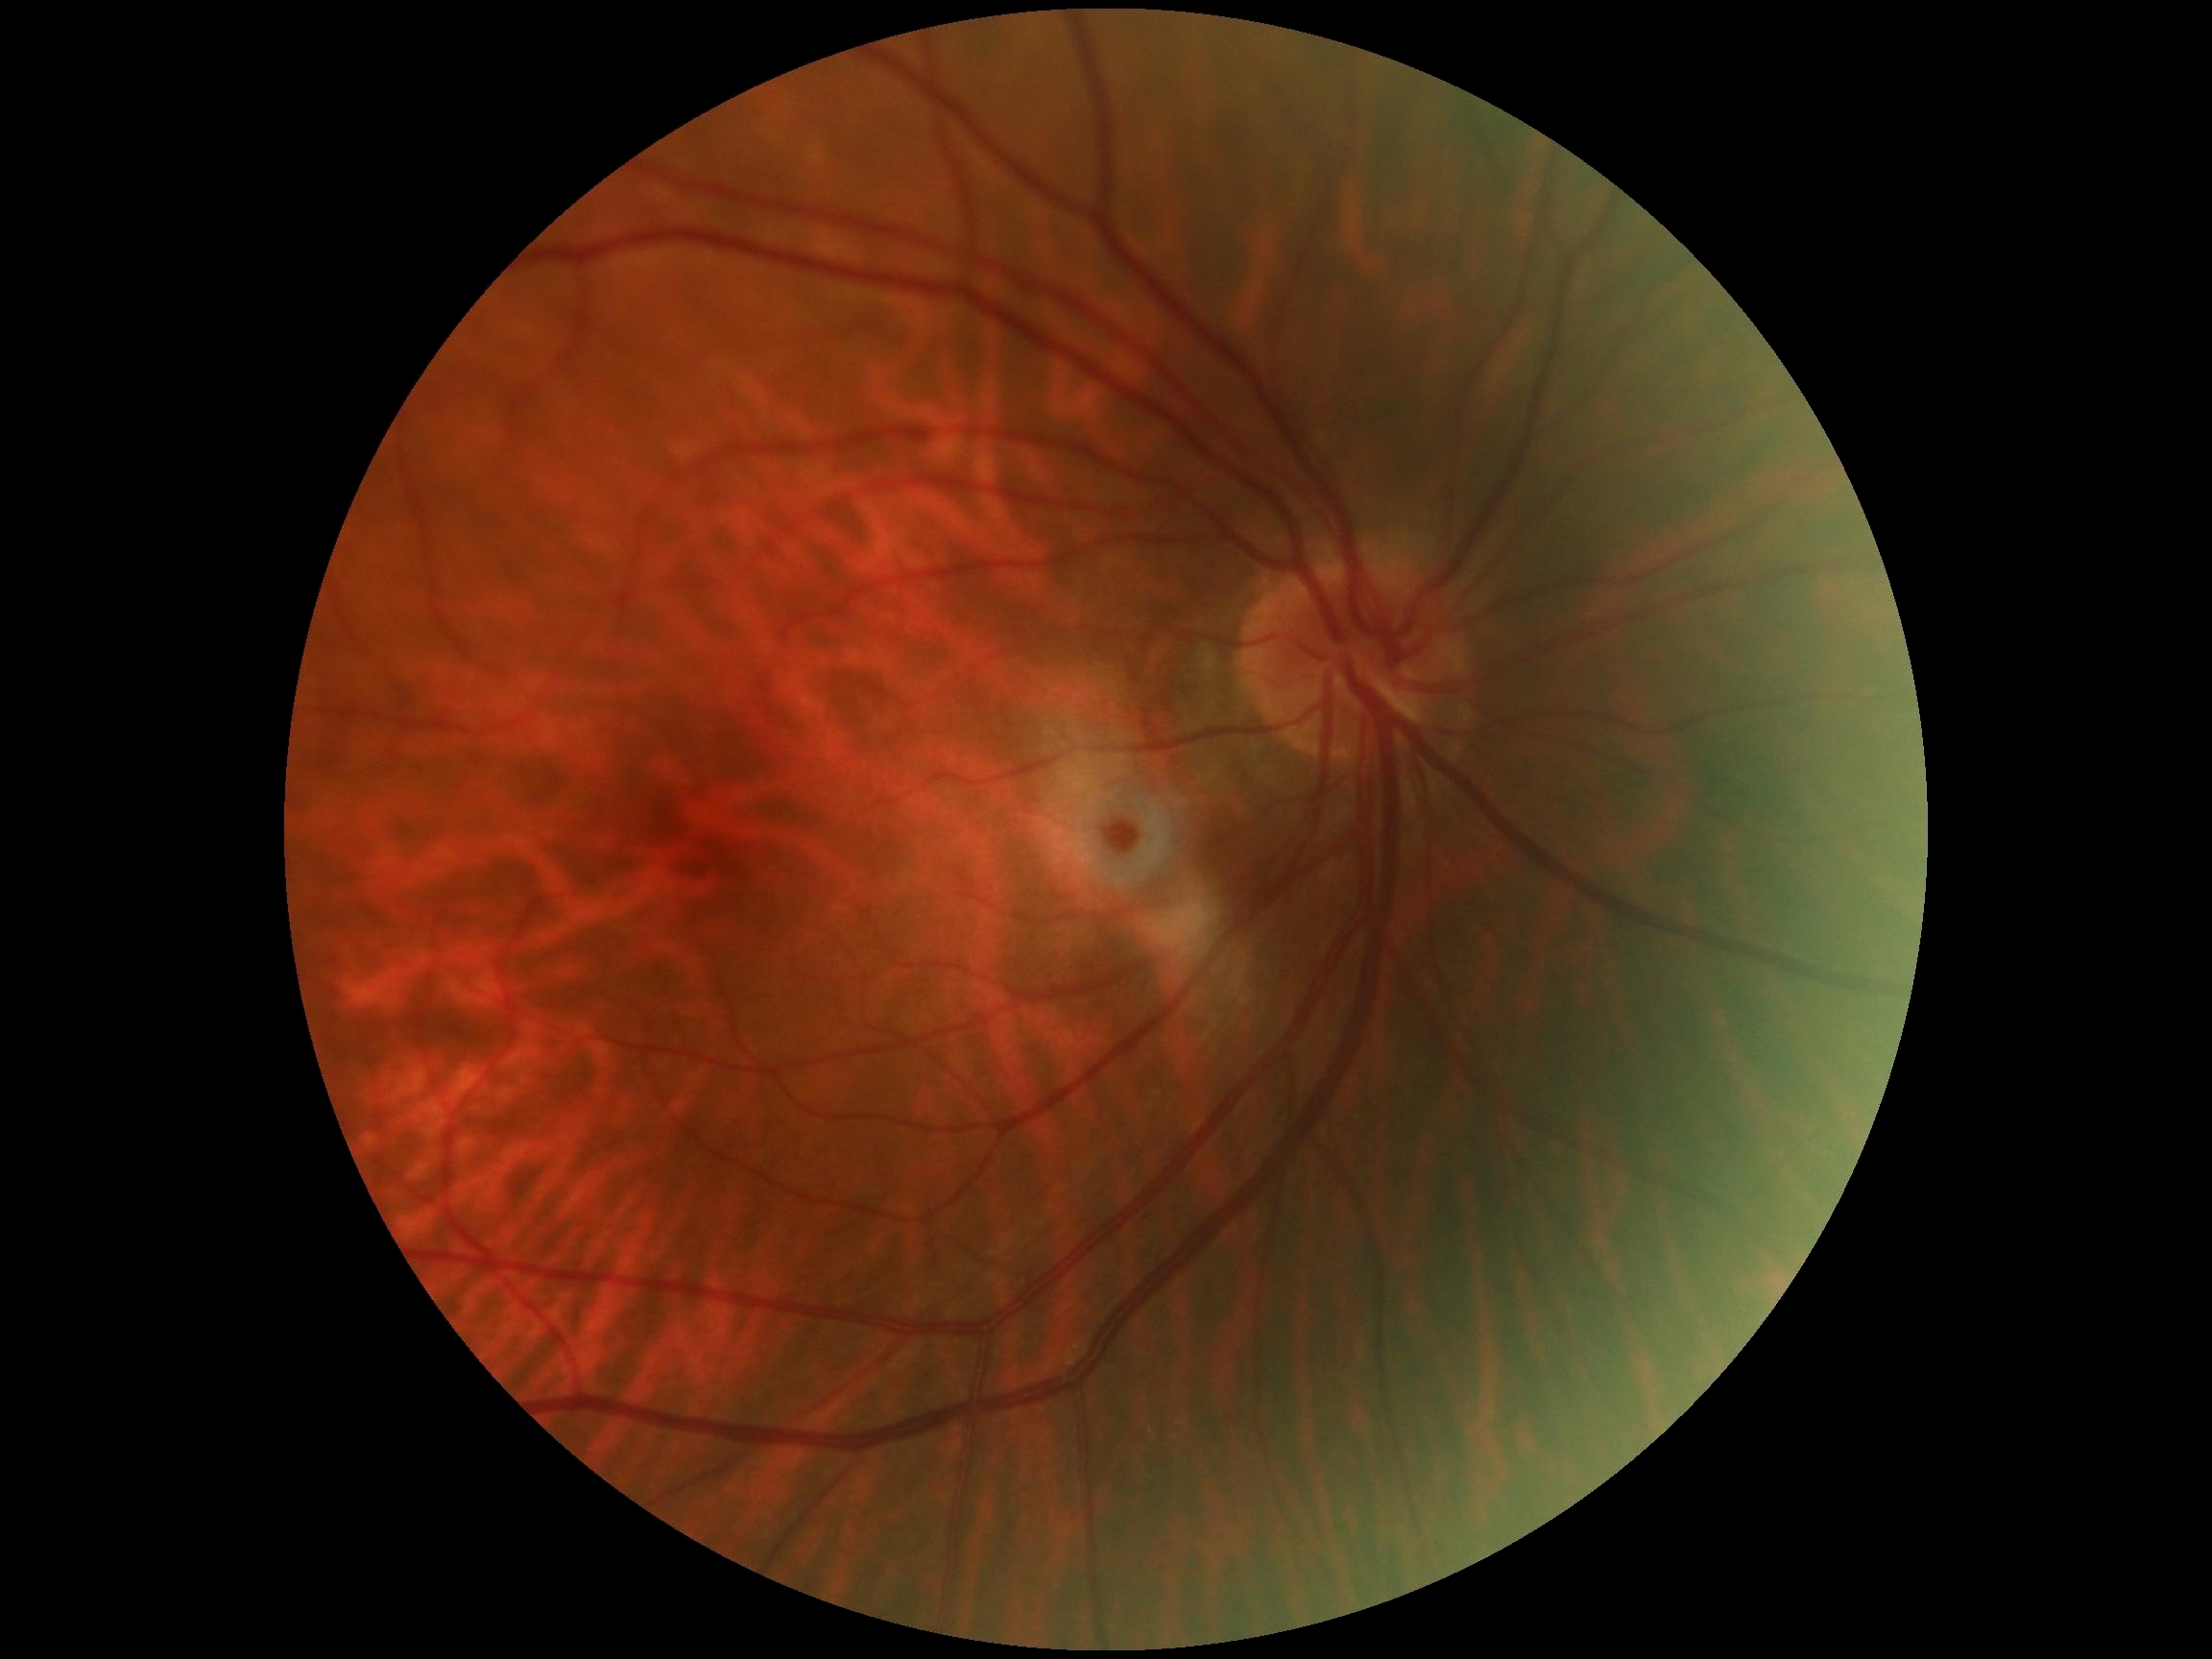
Diabetic retinopathy severity is 0.